Non-mydriatic acquisition:
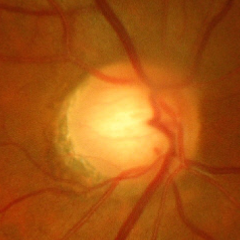

Impression = early glaucoma.